848x848px: 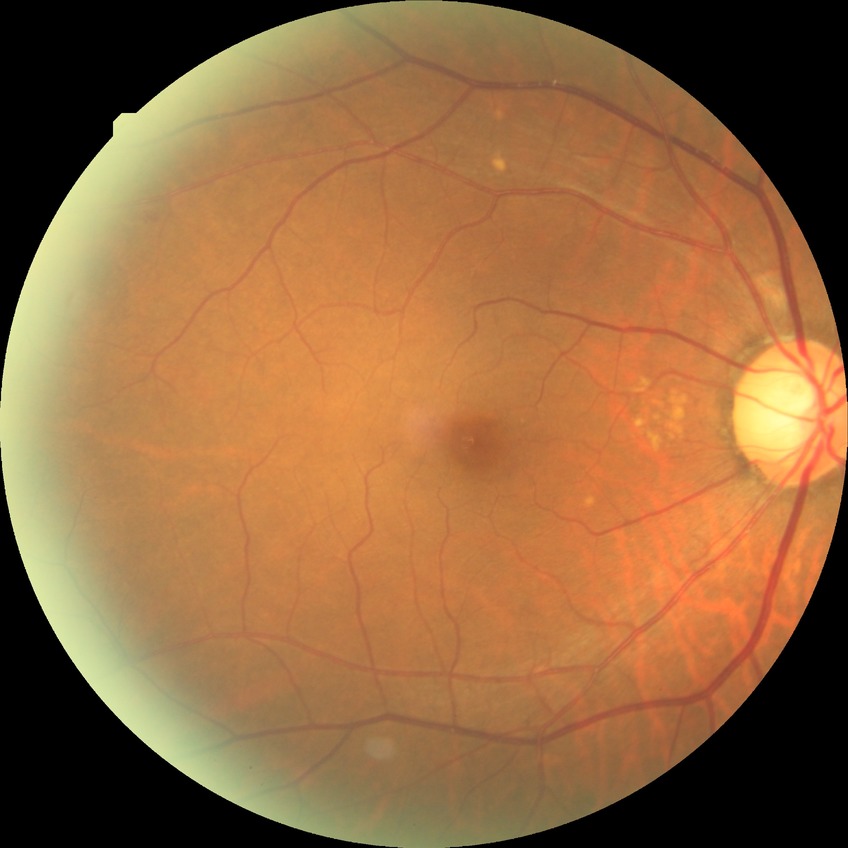

Modified Davis classification is no diabetic retinopathy.